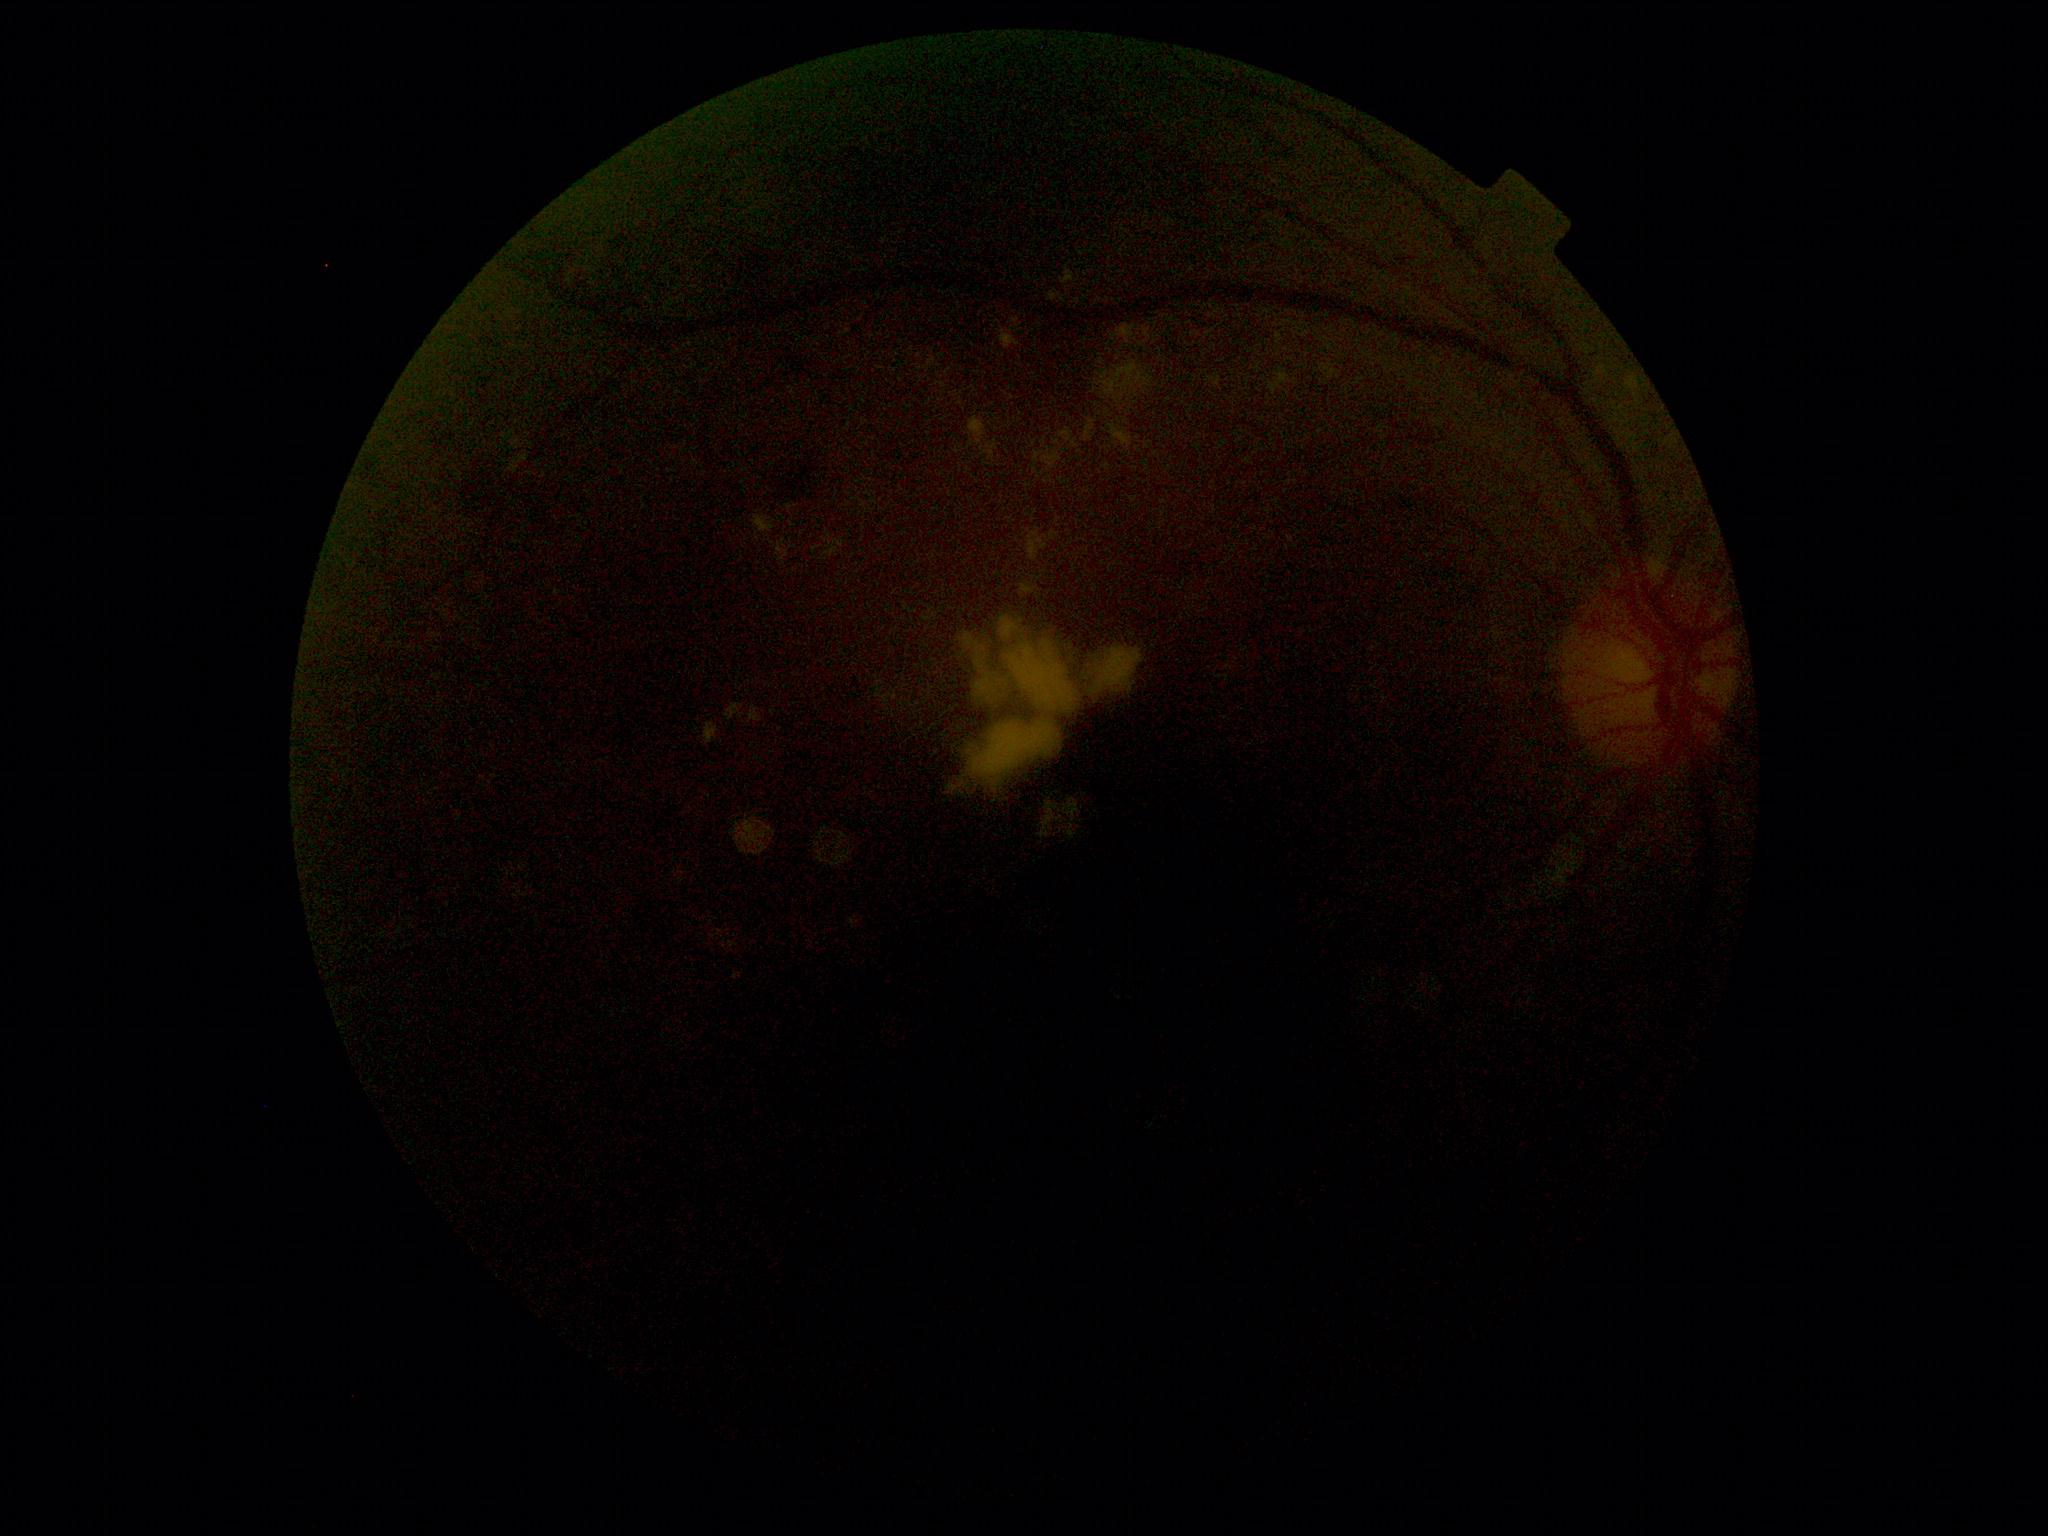
retinopathy = moderate non-proliferative diabetic retinopathy (grade 2).